50° FOV
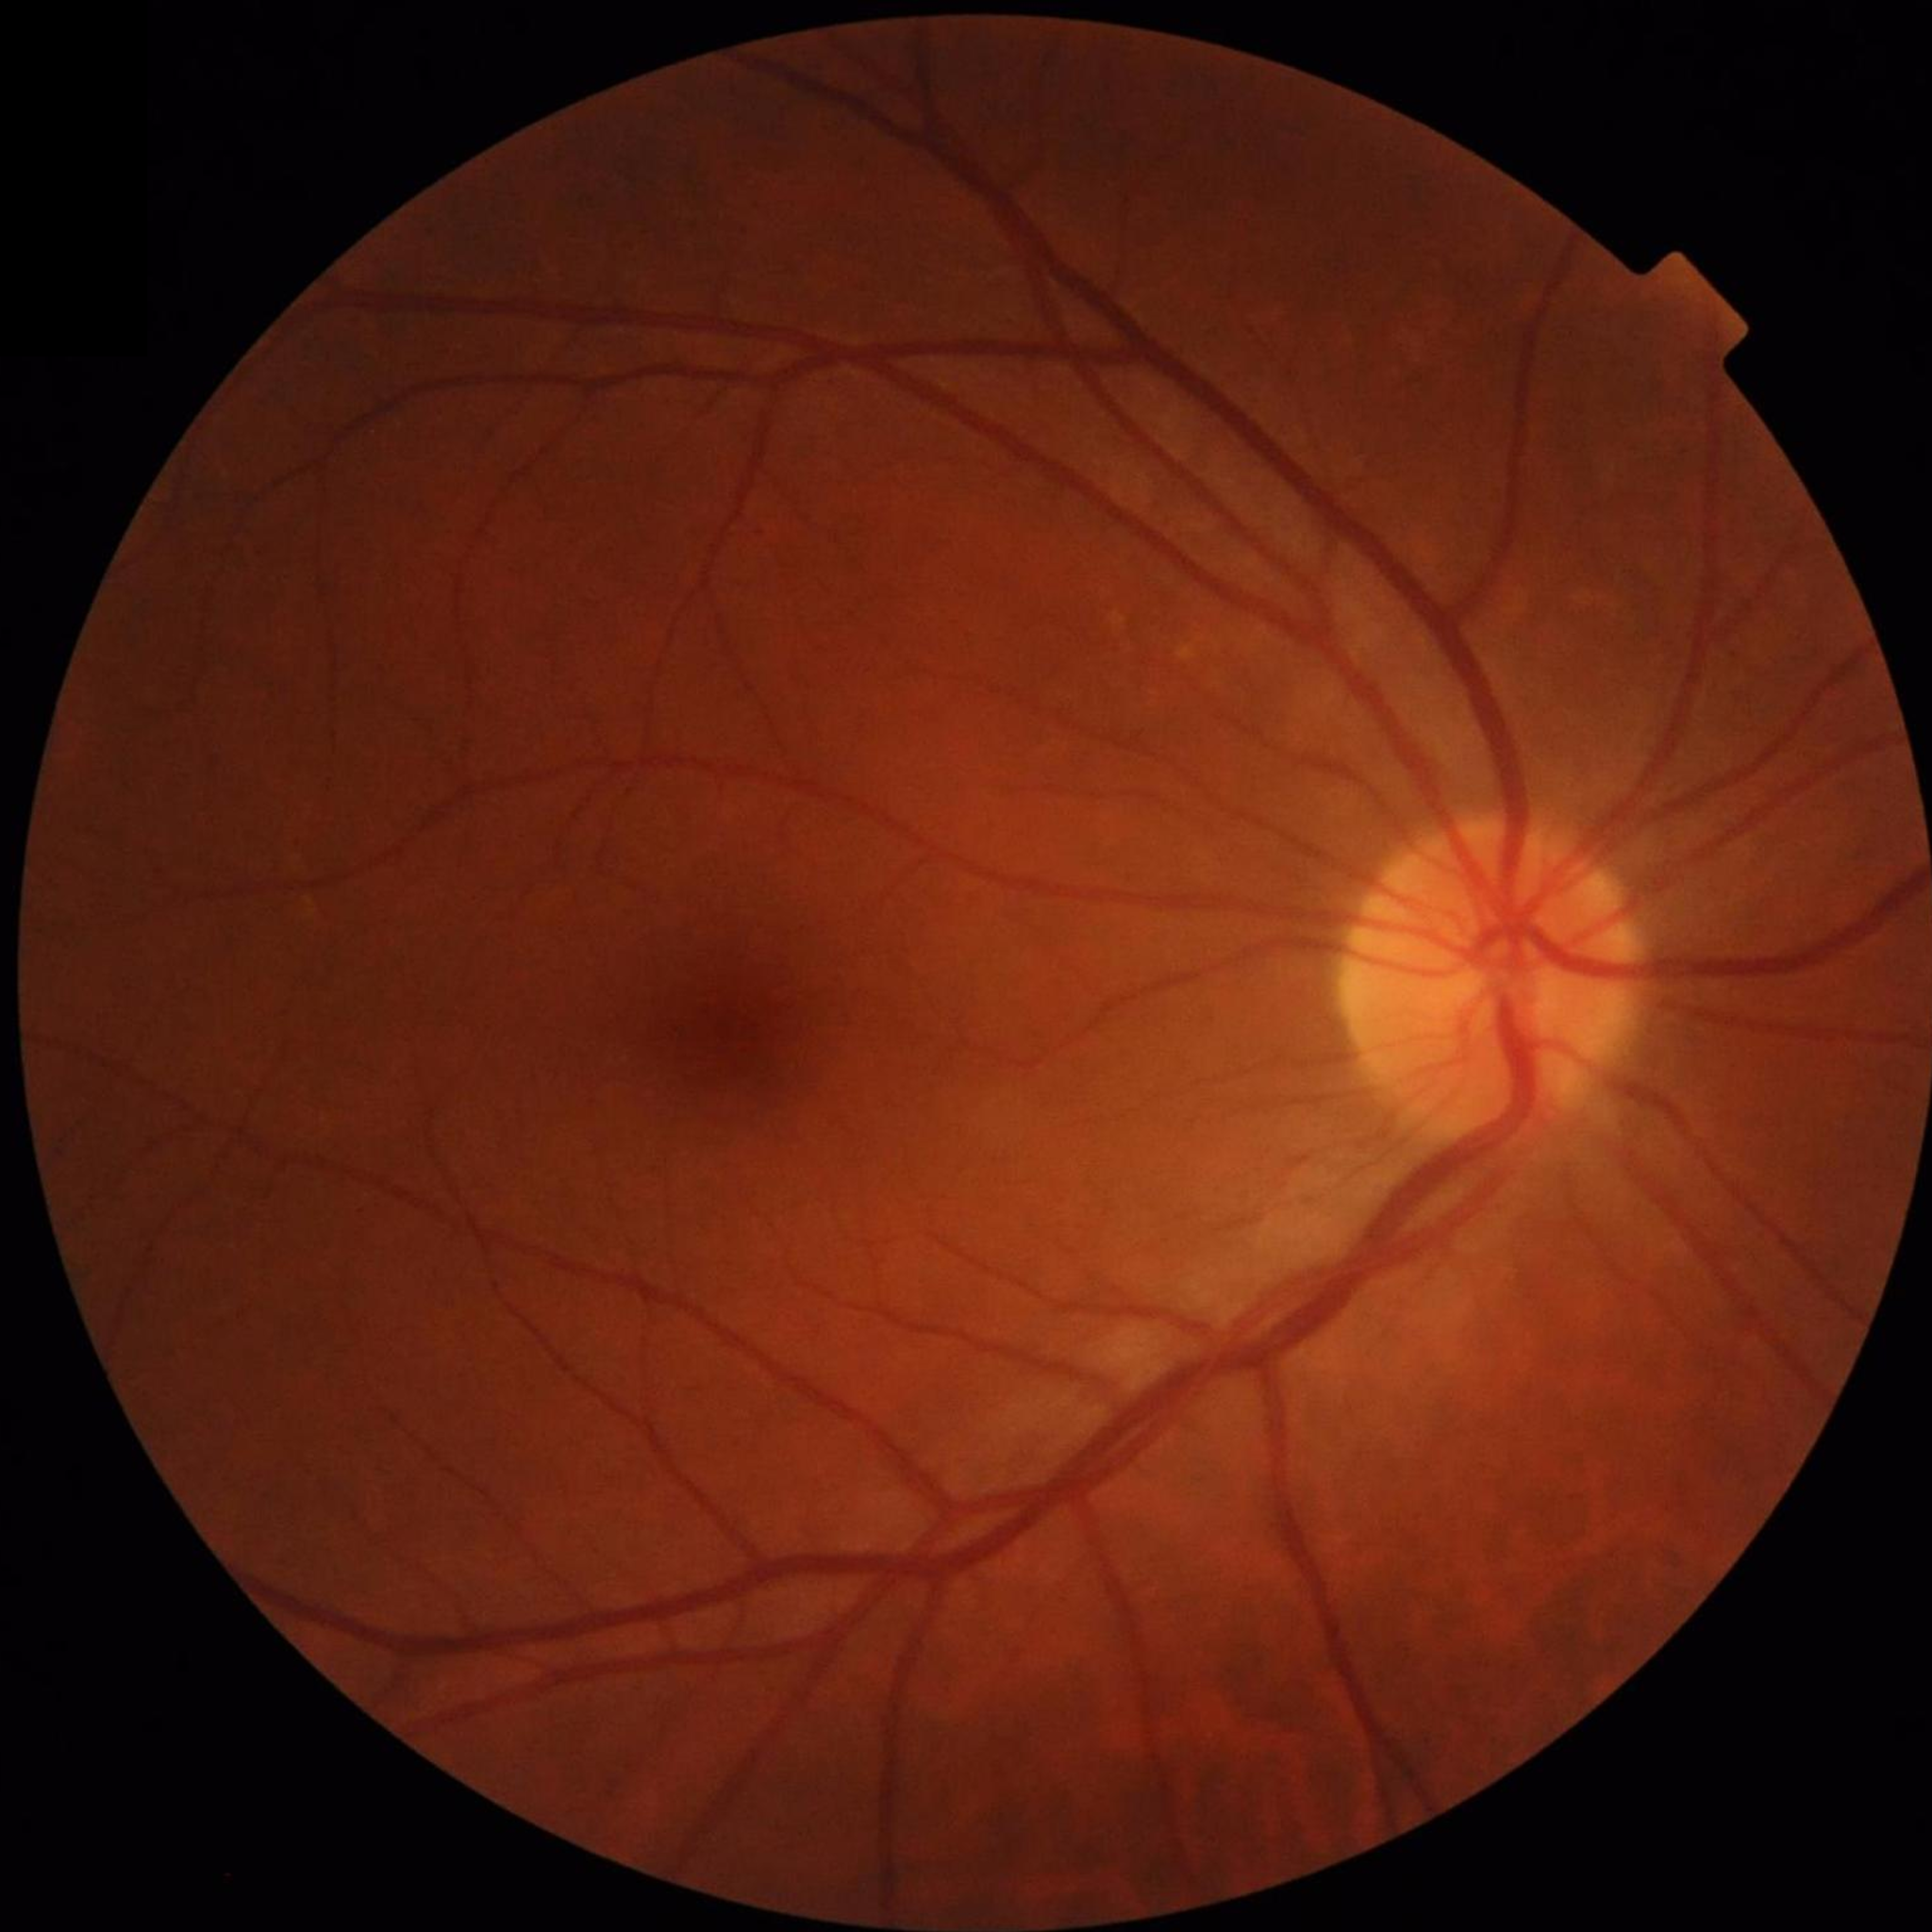
No signs of AMD, diabetic retinopathy, or glaucoma.